1932 by 1916 pixels.
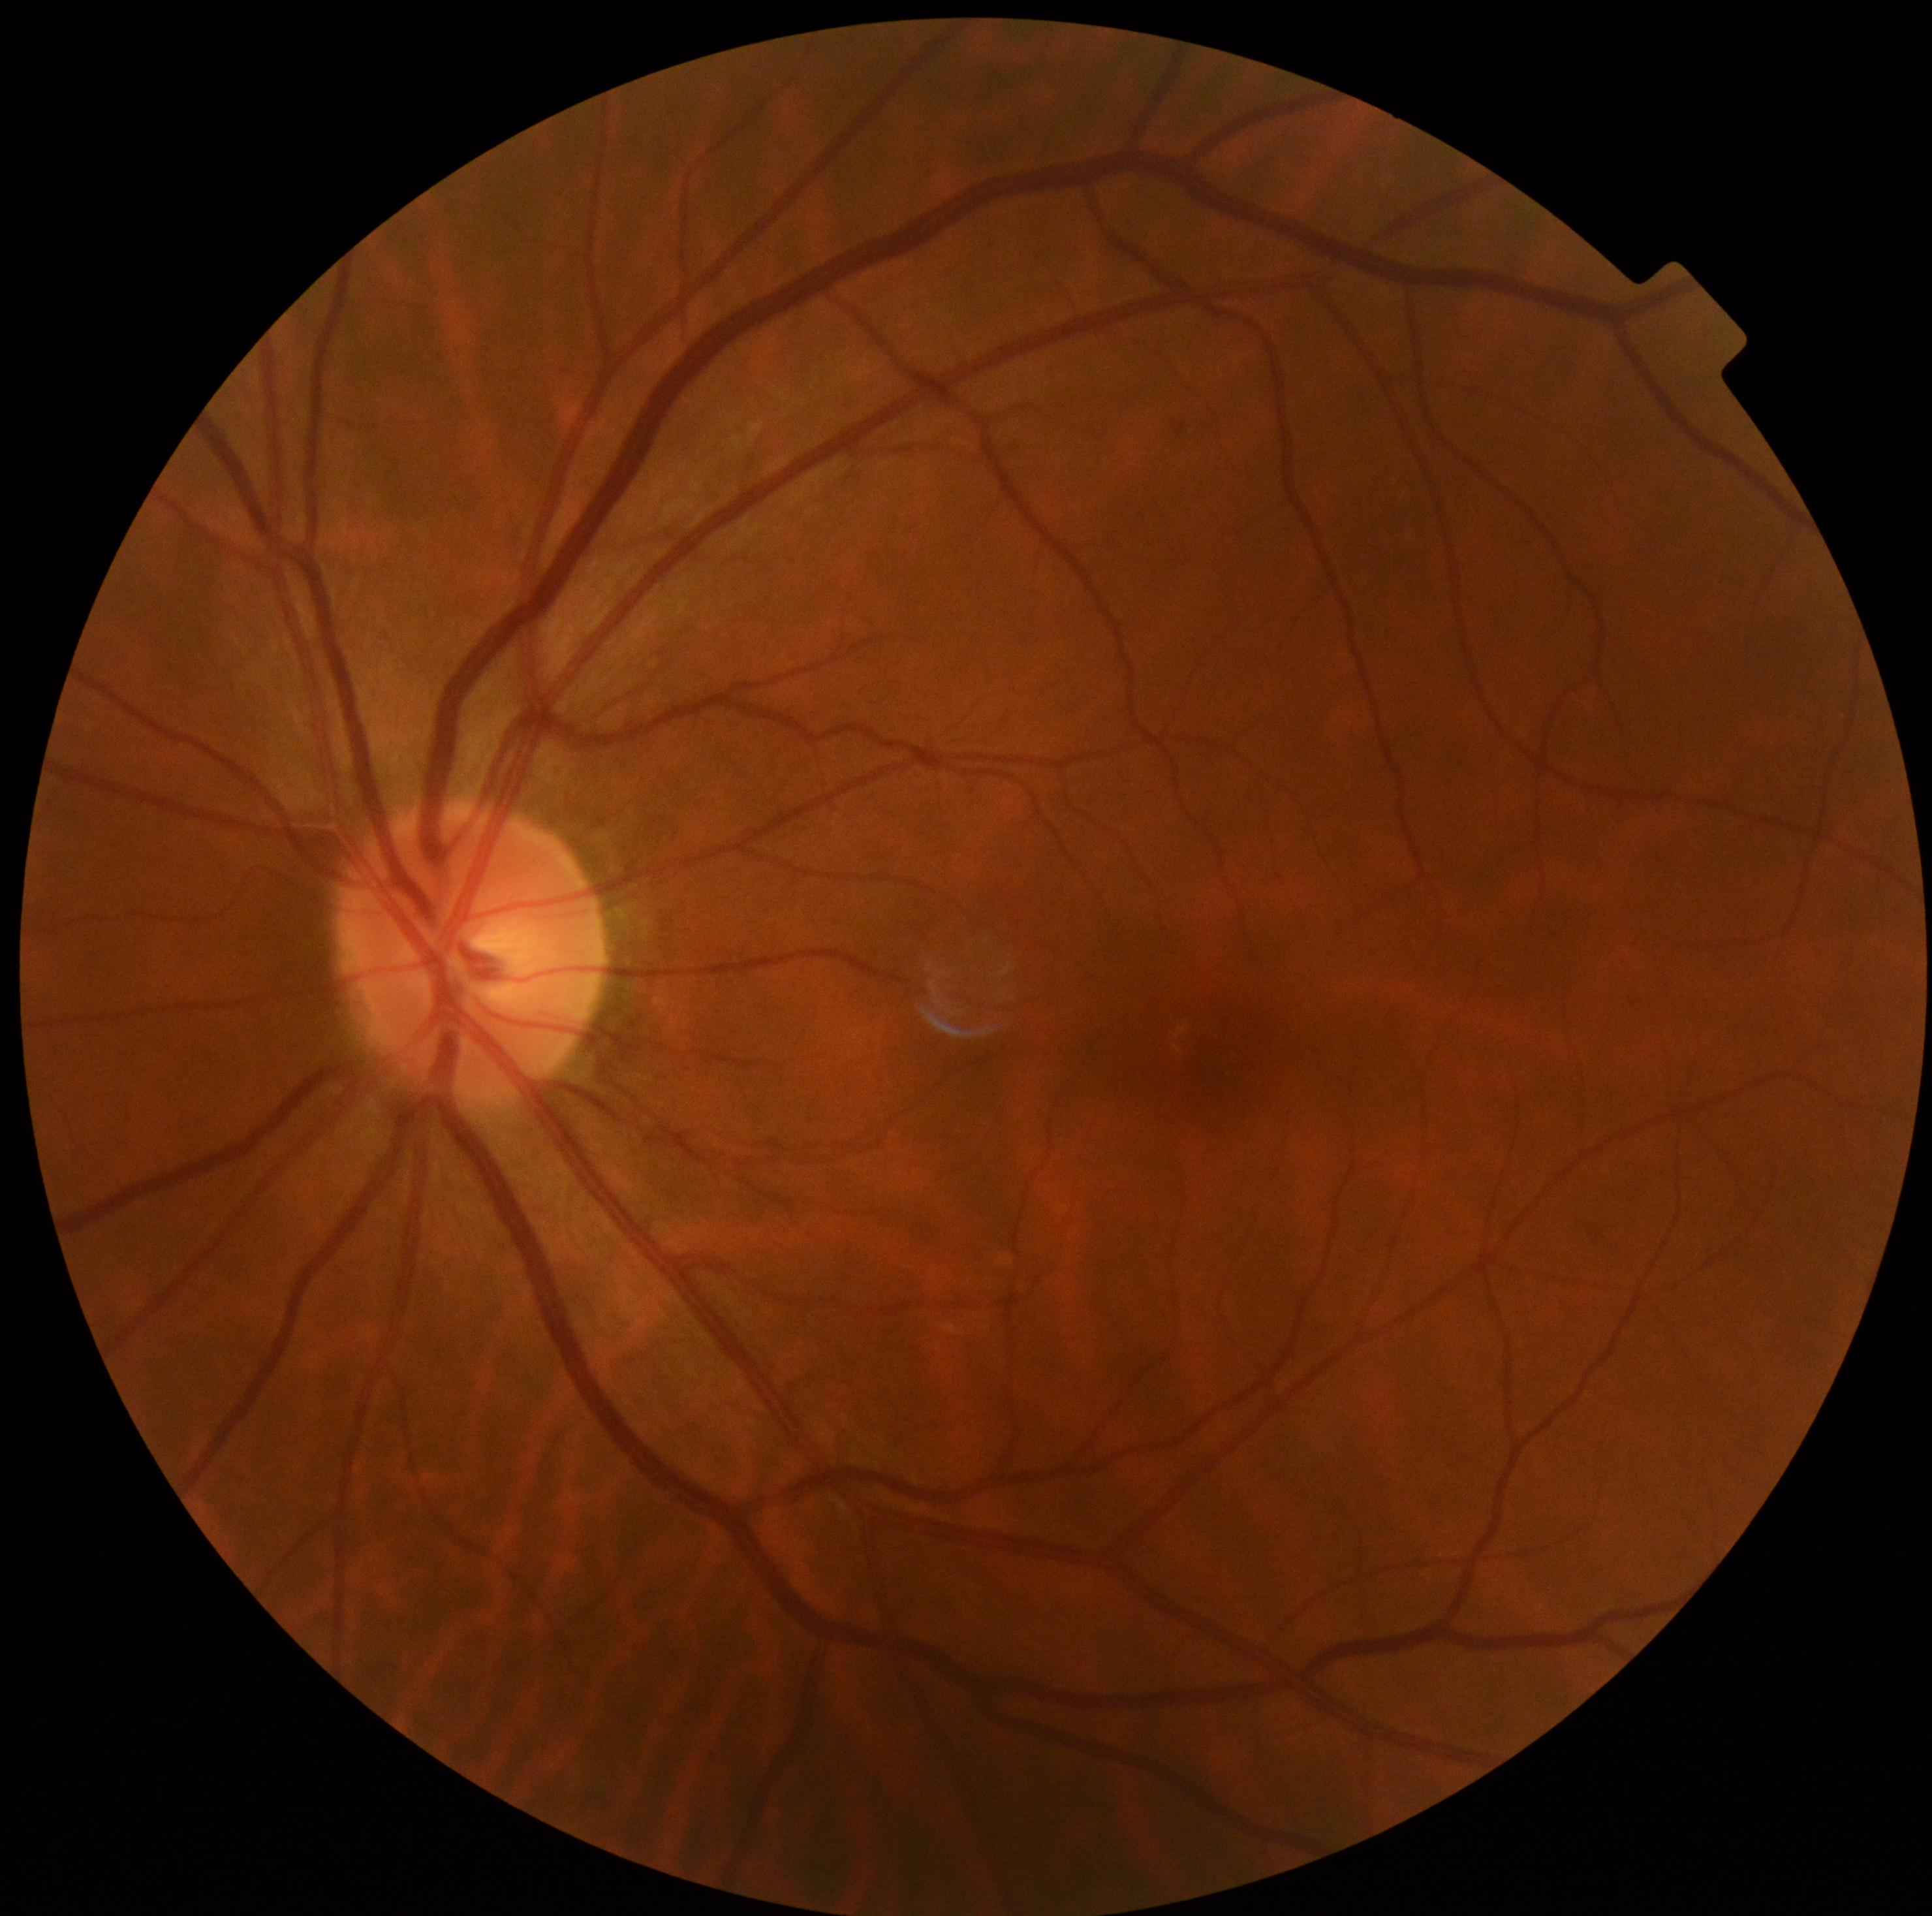
dr_impression: negative for DR
dr_grade: no apparent diabetic retinopathy (grade 0)